45° field of view
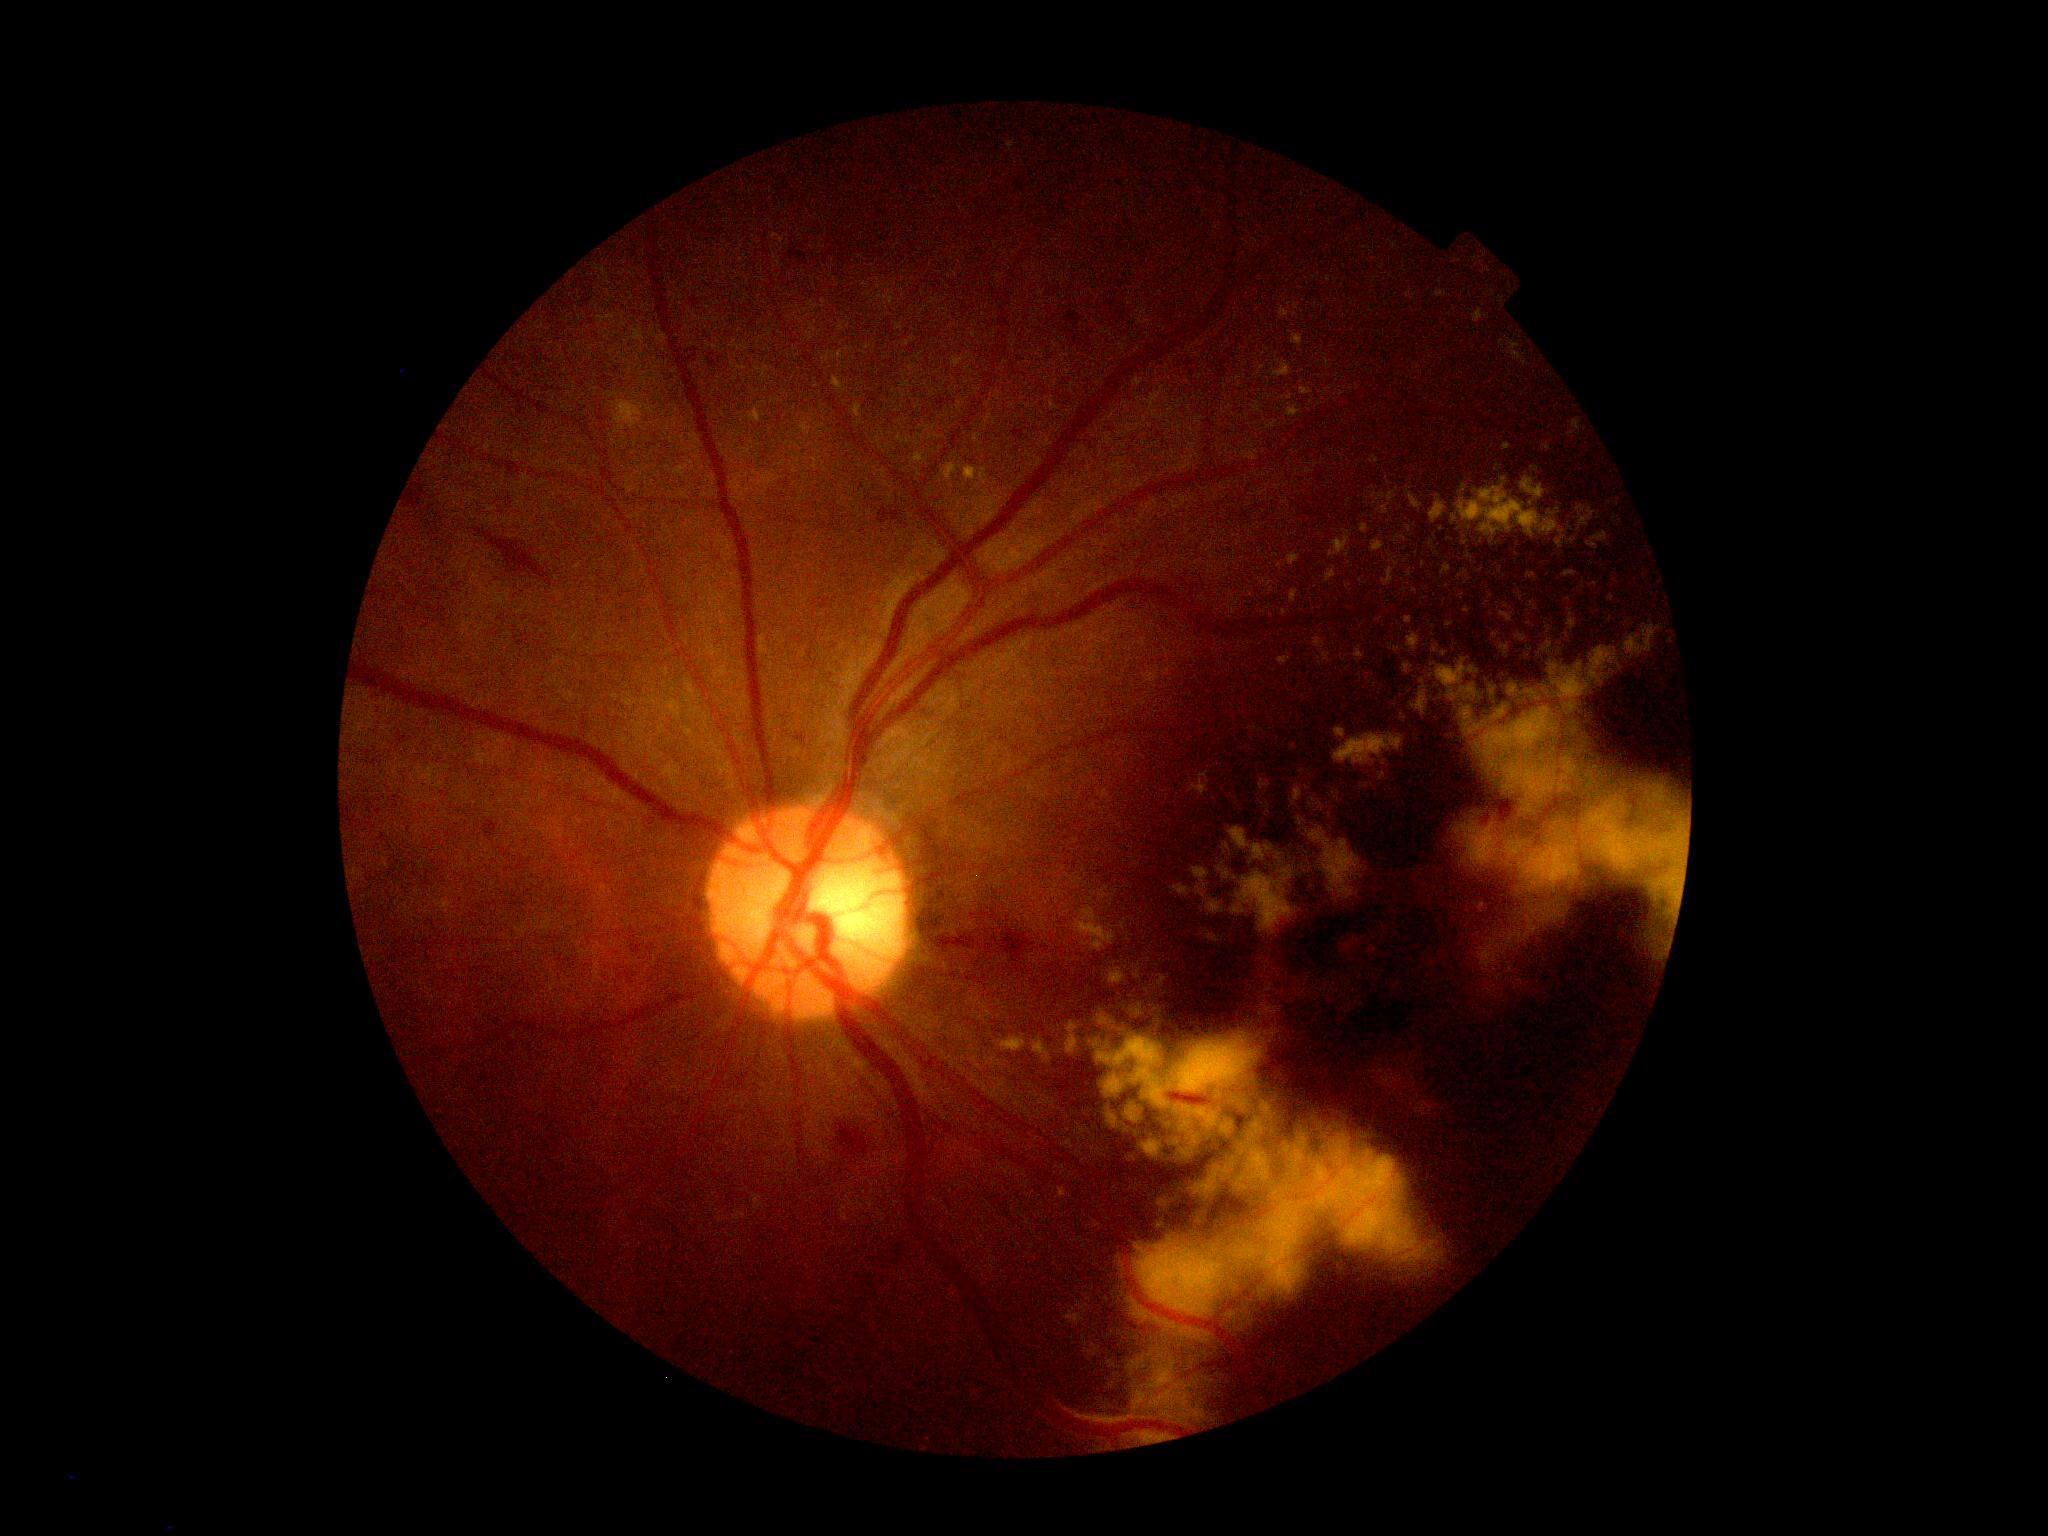 Diabetic retinopathy (DR) is 2/4.